Modified Davis grading
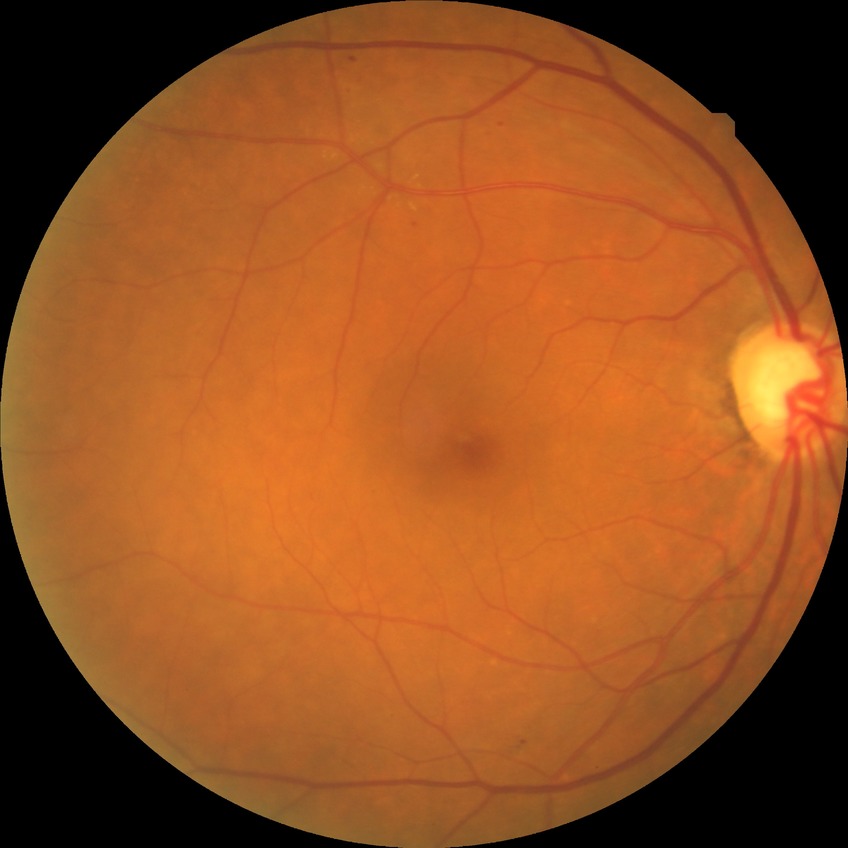 Retinopathy stage: simple diabetic retinopathy.